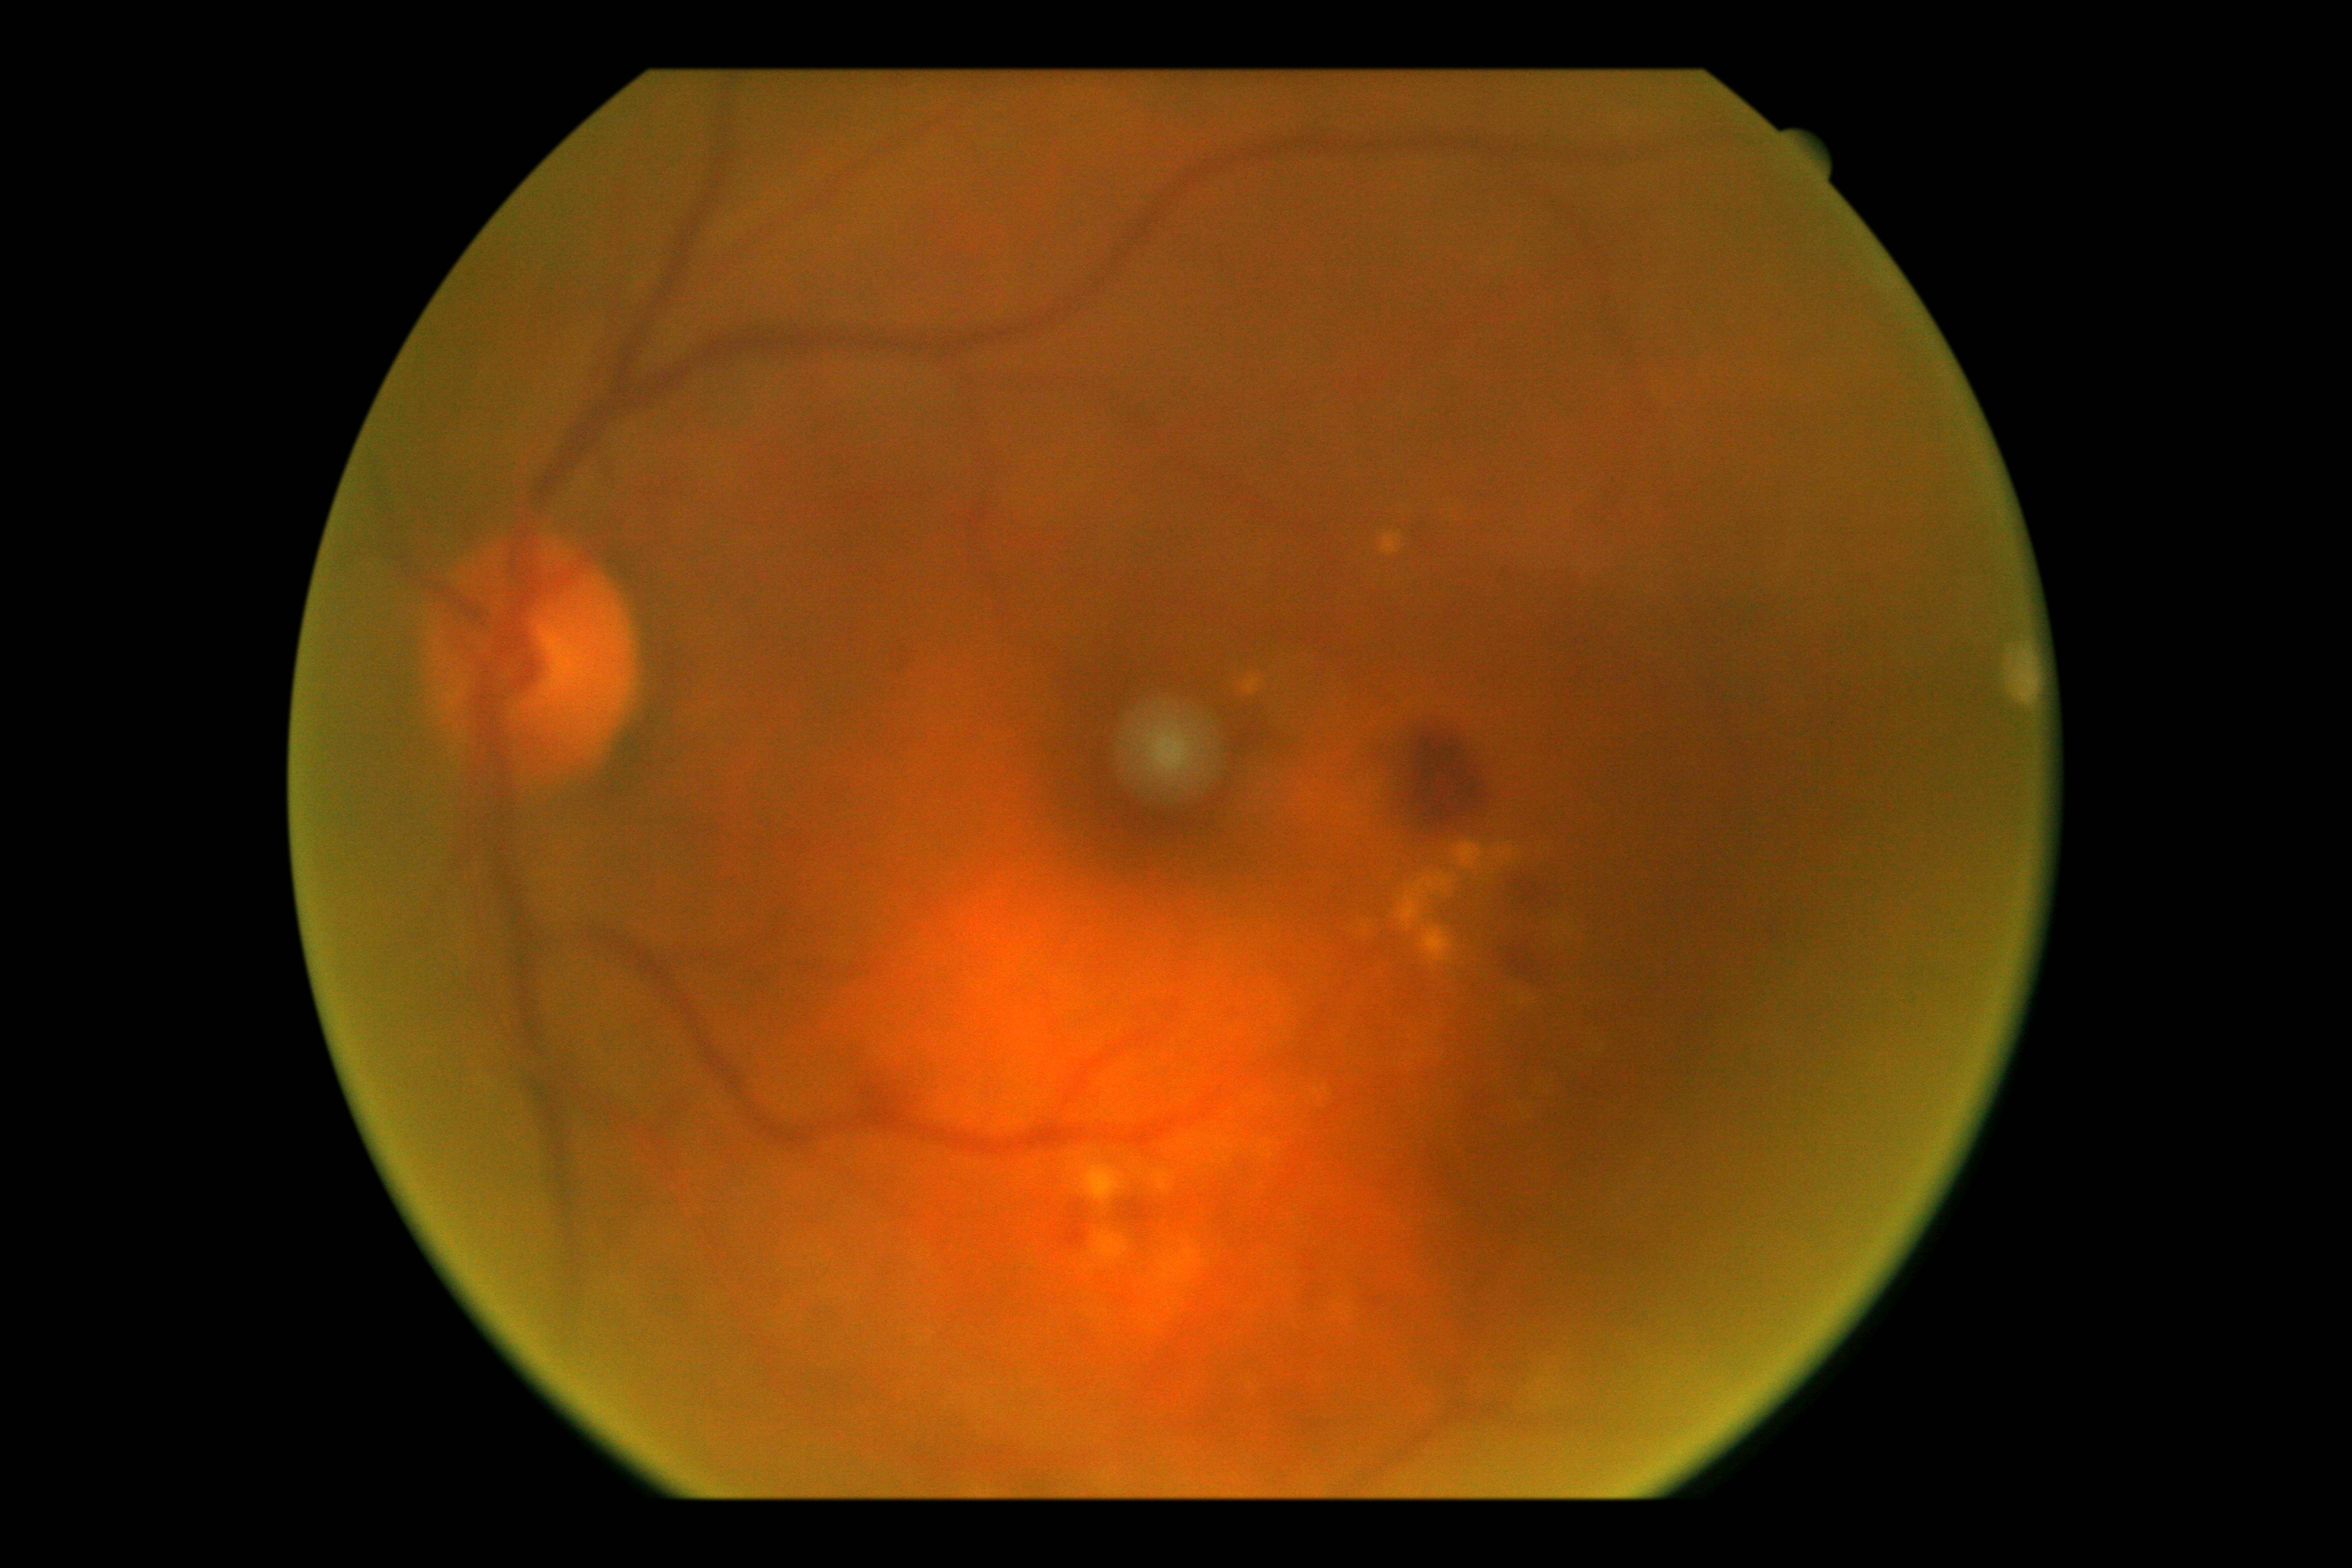

{"dr_grade": "grade 2"}